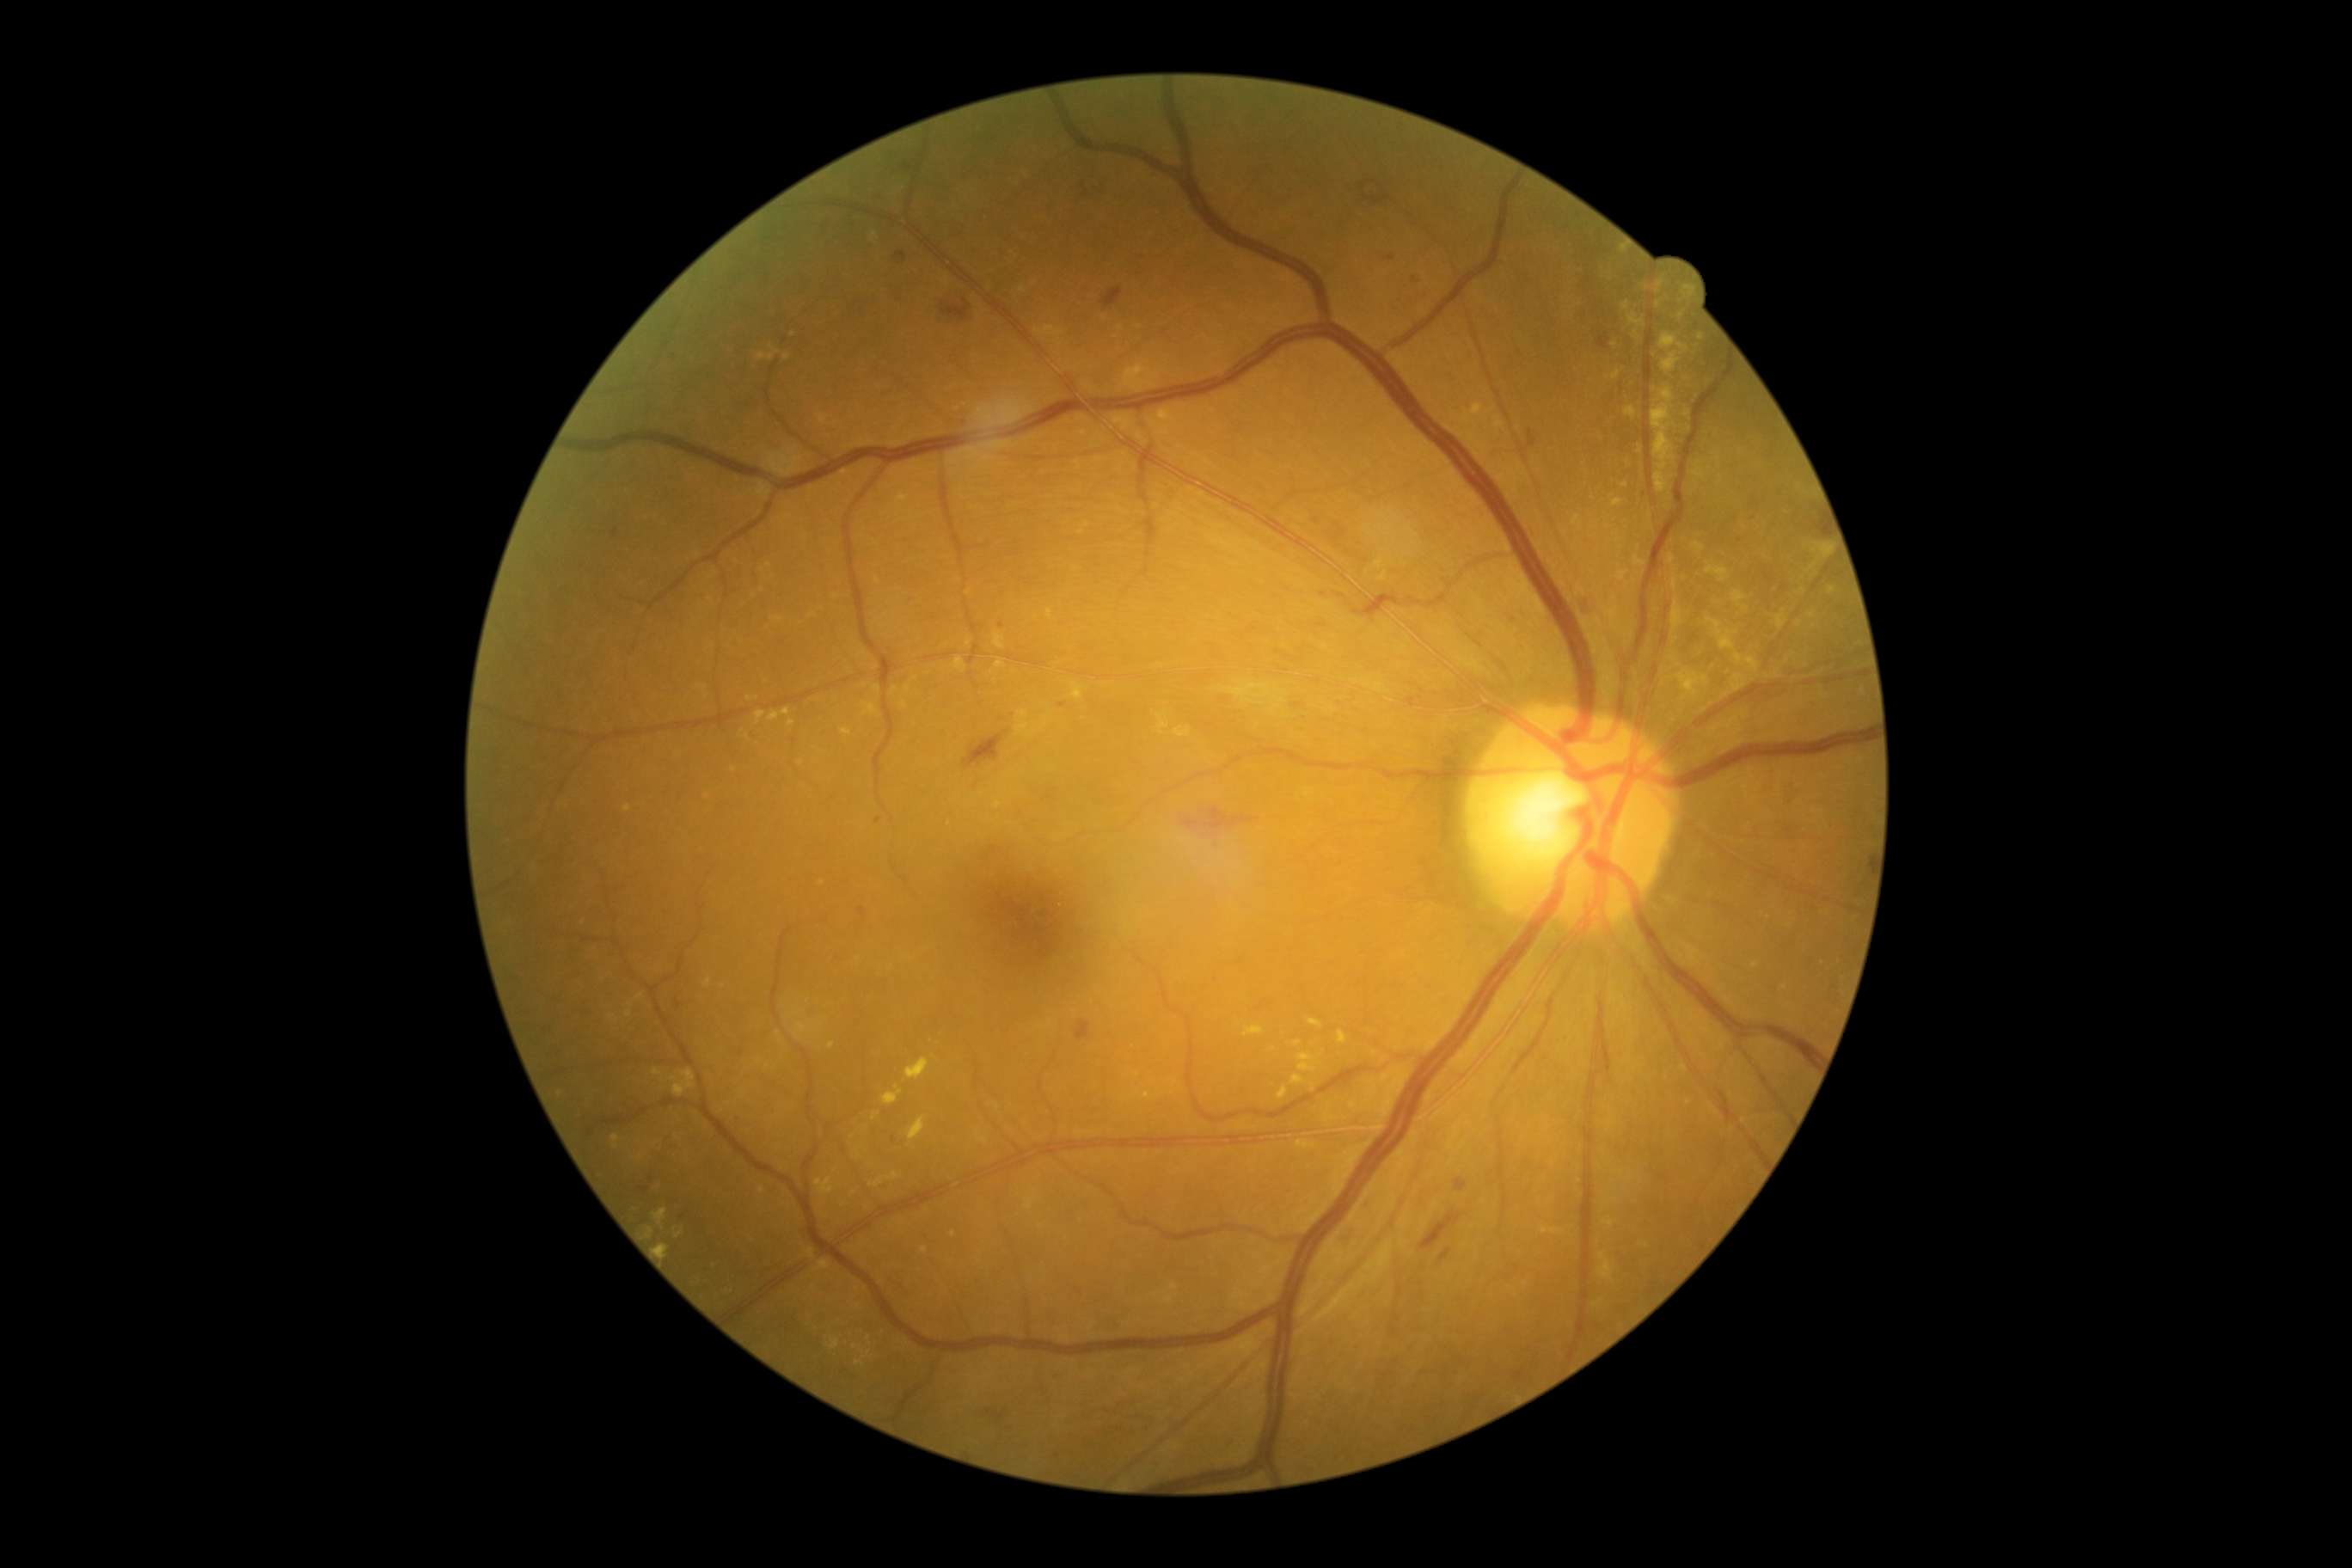
Diabetic retinopathy (DR): grade 2
Representative lesions:
hard exudates (EXs) (partial): [left=1017, top=721, right=1029, bottom=735] | [left=1309, top=1019, right=1323, bottom=1029] | [left=1627, top=314, right=1646, bottom=328] | [left=907, top=685, right=910, bottom=694] | [left=1651, top=384, right=1675, bottom=493] | [left=1294, top=1041, right=1302, bottom=1048] | [left=857, top=652, right=866, bottom=658] | [left=1808, top=565, right=1816, bottom=573] | [left=1598, top=1253, right=1614, bottom=1283] | [left=1682, top=286, right=1693, bottom=298] | [left=1681, top=670, right=1710, bottom=690] | [left=1244, top=1027, right=1265, bottom=1038] | [left=1278, top=1087, right=1287, bottom=1099]
Small EXs near (1623, 251) | (859, 1154) | (1803, 591) | (1681, 317) | (1614, 345)
microaneurysms (MAs) (partial): [left=1041, top=1388, right=1048, bottom=1397] | [left=649, top=1175, right=656, bottom=1184] | [left=1412, top=276, right=1419, bottom=285] | [left=1290, top=702, right=1302, bottom=709] | [left=1509, top=616, right=1521, bottom=625] | [left=637, top=1187, right=651, bottom=1196] | [left=857, top=907, right=867, bottom=926] | [left=1522, top=1349, right=1531, bottom=1354] | [left=673, top=1000, right=685, bottom=1012] | [left=1058, top=702, right=1069, bottom=709]
Small MAs near (895, 1140) | (790, 718) | (1001, 626) | (1224, 700)
soft exudates (SEs): [left=1222, top=682, right=1287, bottom=706]
hemorrhages (HEs) (partial): [left=1075, top=1019, right=1091, bottom=1041] | [left=1419, top=1210, right=1466, bottom=1251] | [left=1813, top=522, right=1828, bottom=539] | [left=1335, top=594, right=1345, bottom=599] | [left=984, top=845, right=998, bottom=861] | [left=1326, top=520, right=1359, bottom=558] | [left=1528, top=429, right=1536, bottom=448] | [left=1256, top=1001, right=1273, bottom=1012] | [left=1440, top=1247, right=1454, bottom=1265] | [left=1179, top=807, right=1261, bottom=838] | [left=981, top=1407, right=1010, bottom=1430]
Small HEs near (1010, 1429)